Color fundus photograph
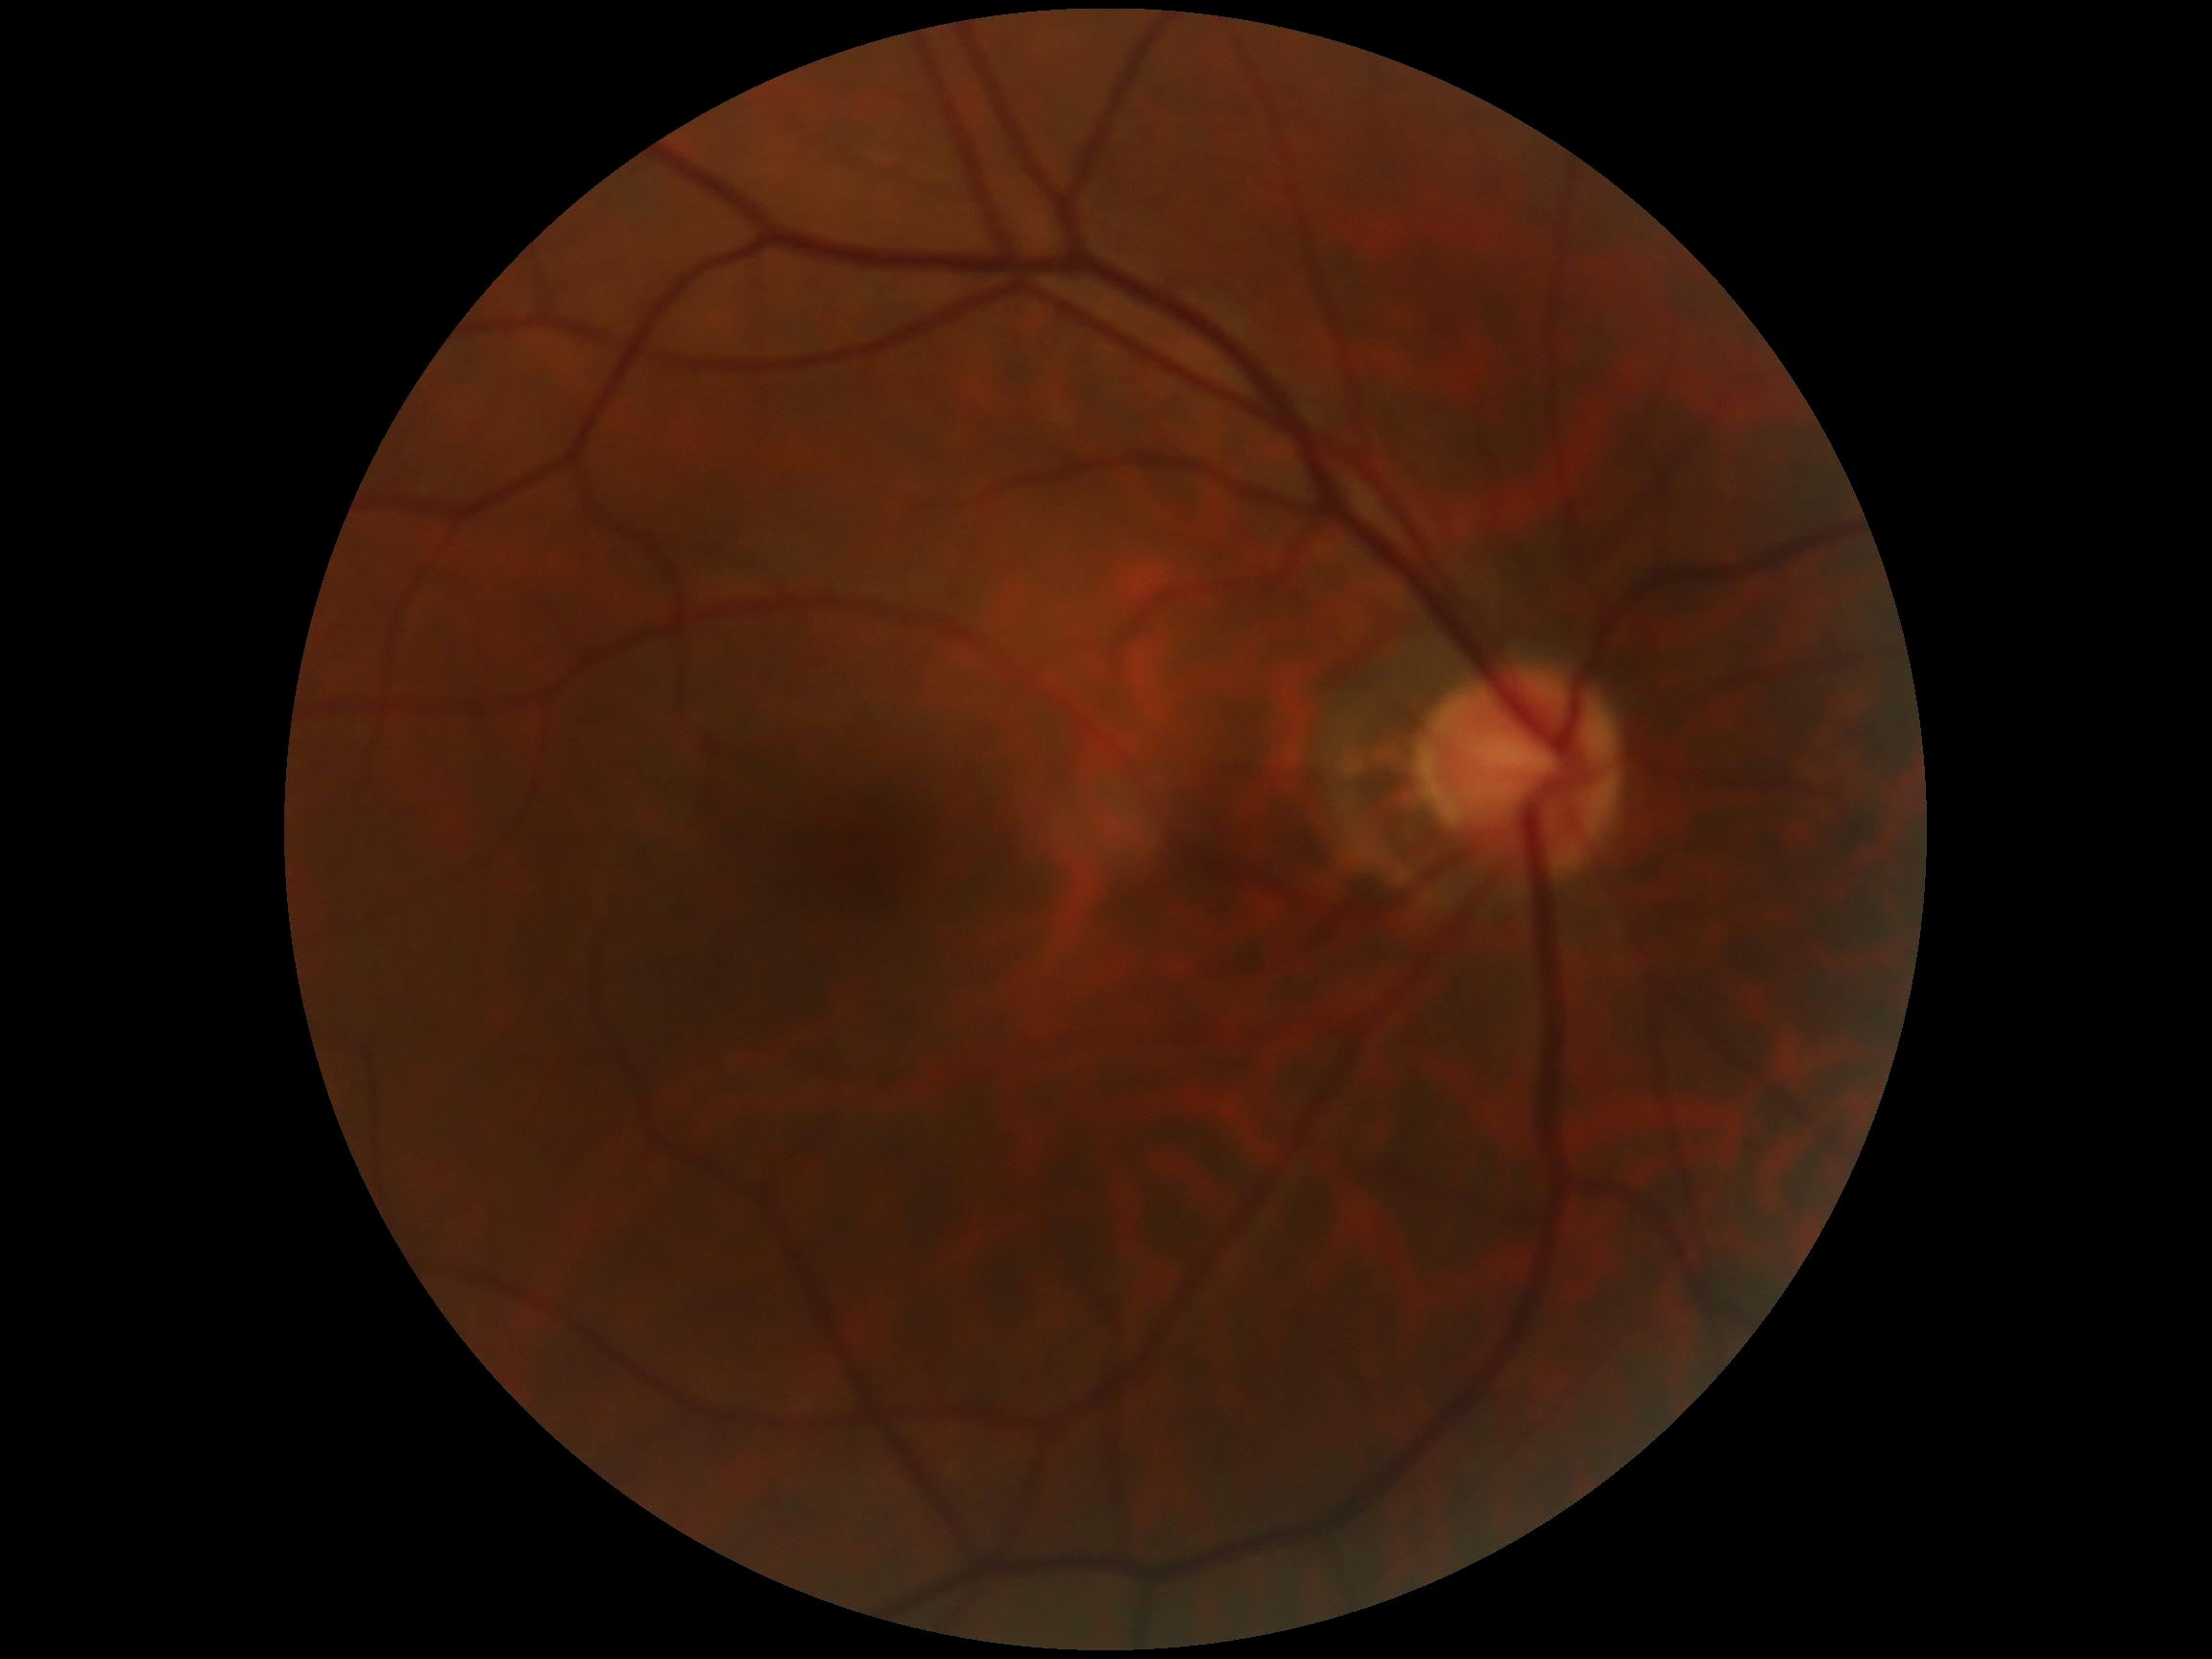

DR severity = grade 0